Retinal fundus photograph
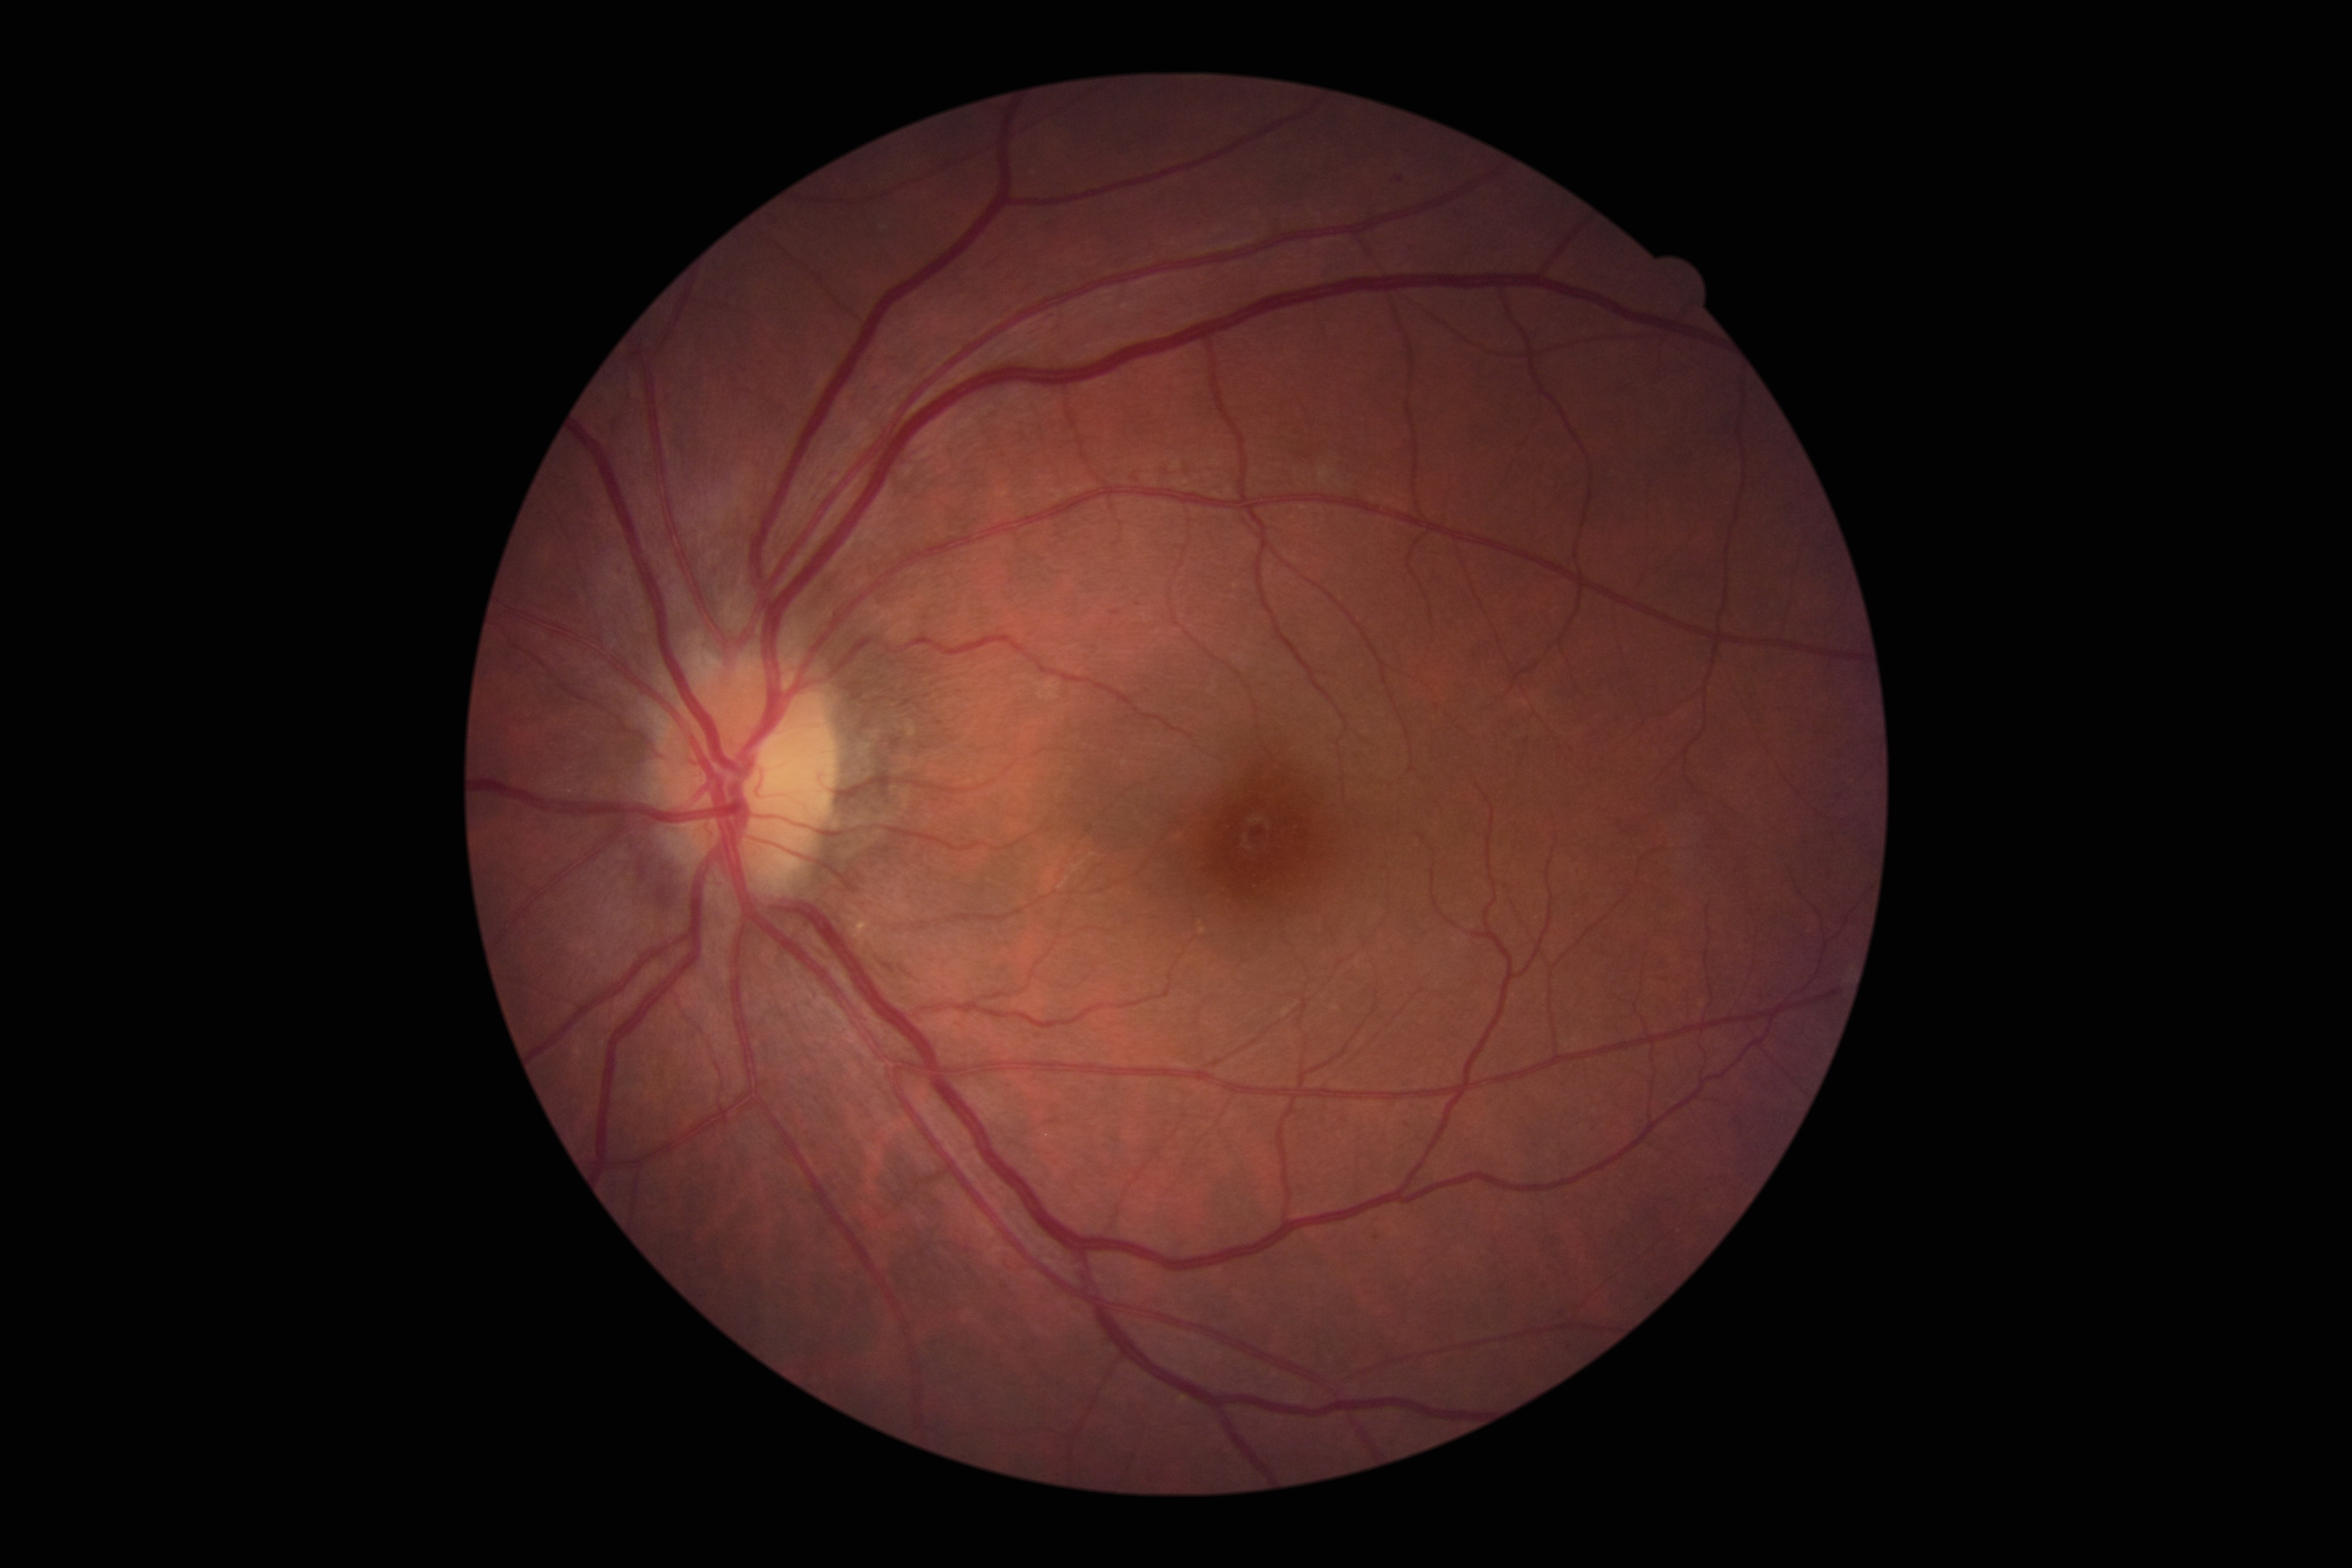
Diabetic retinopathy (DR) is grade 1 (mild NPDR) — presence of microaneurysms only.